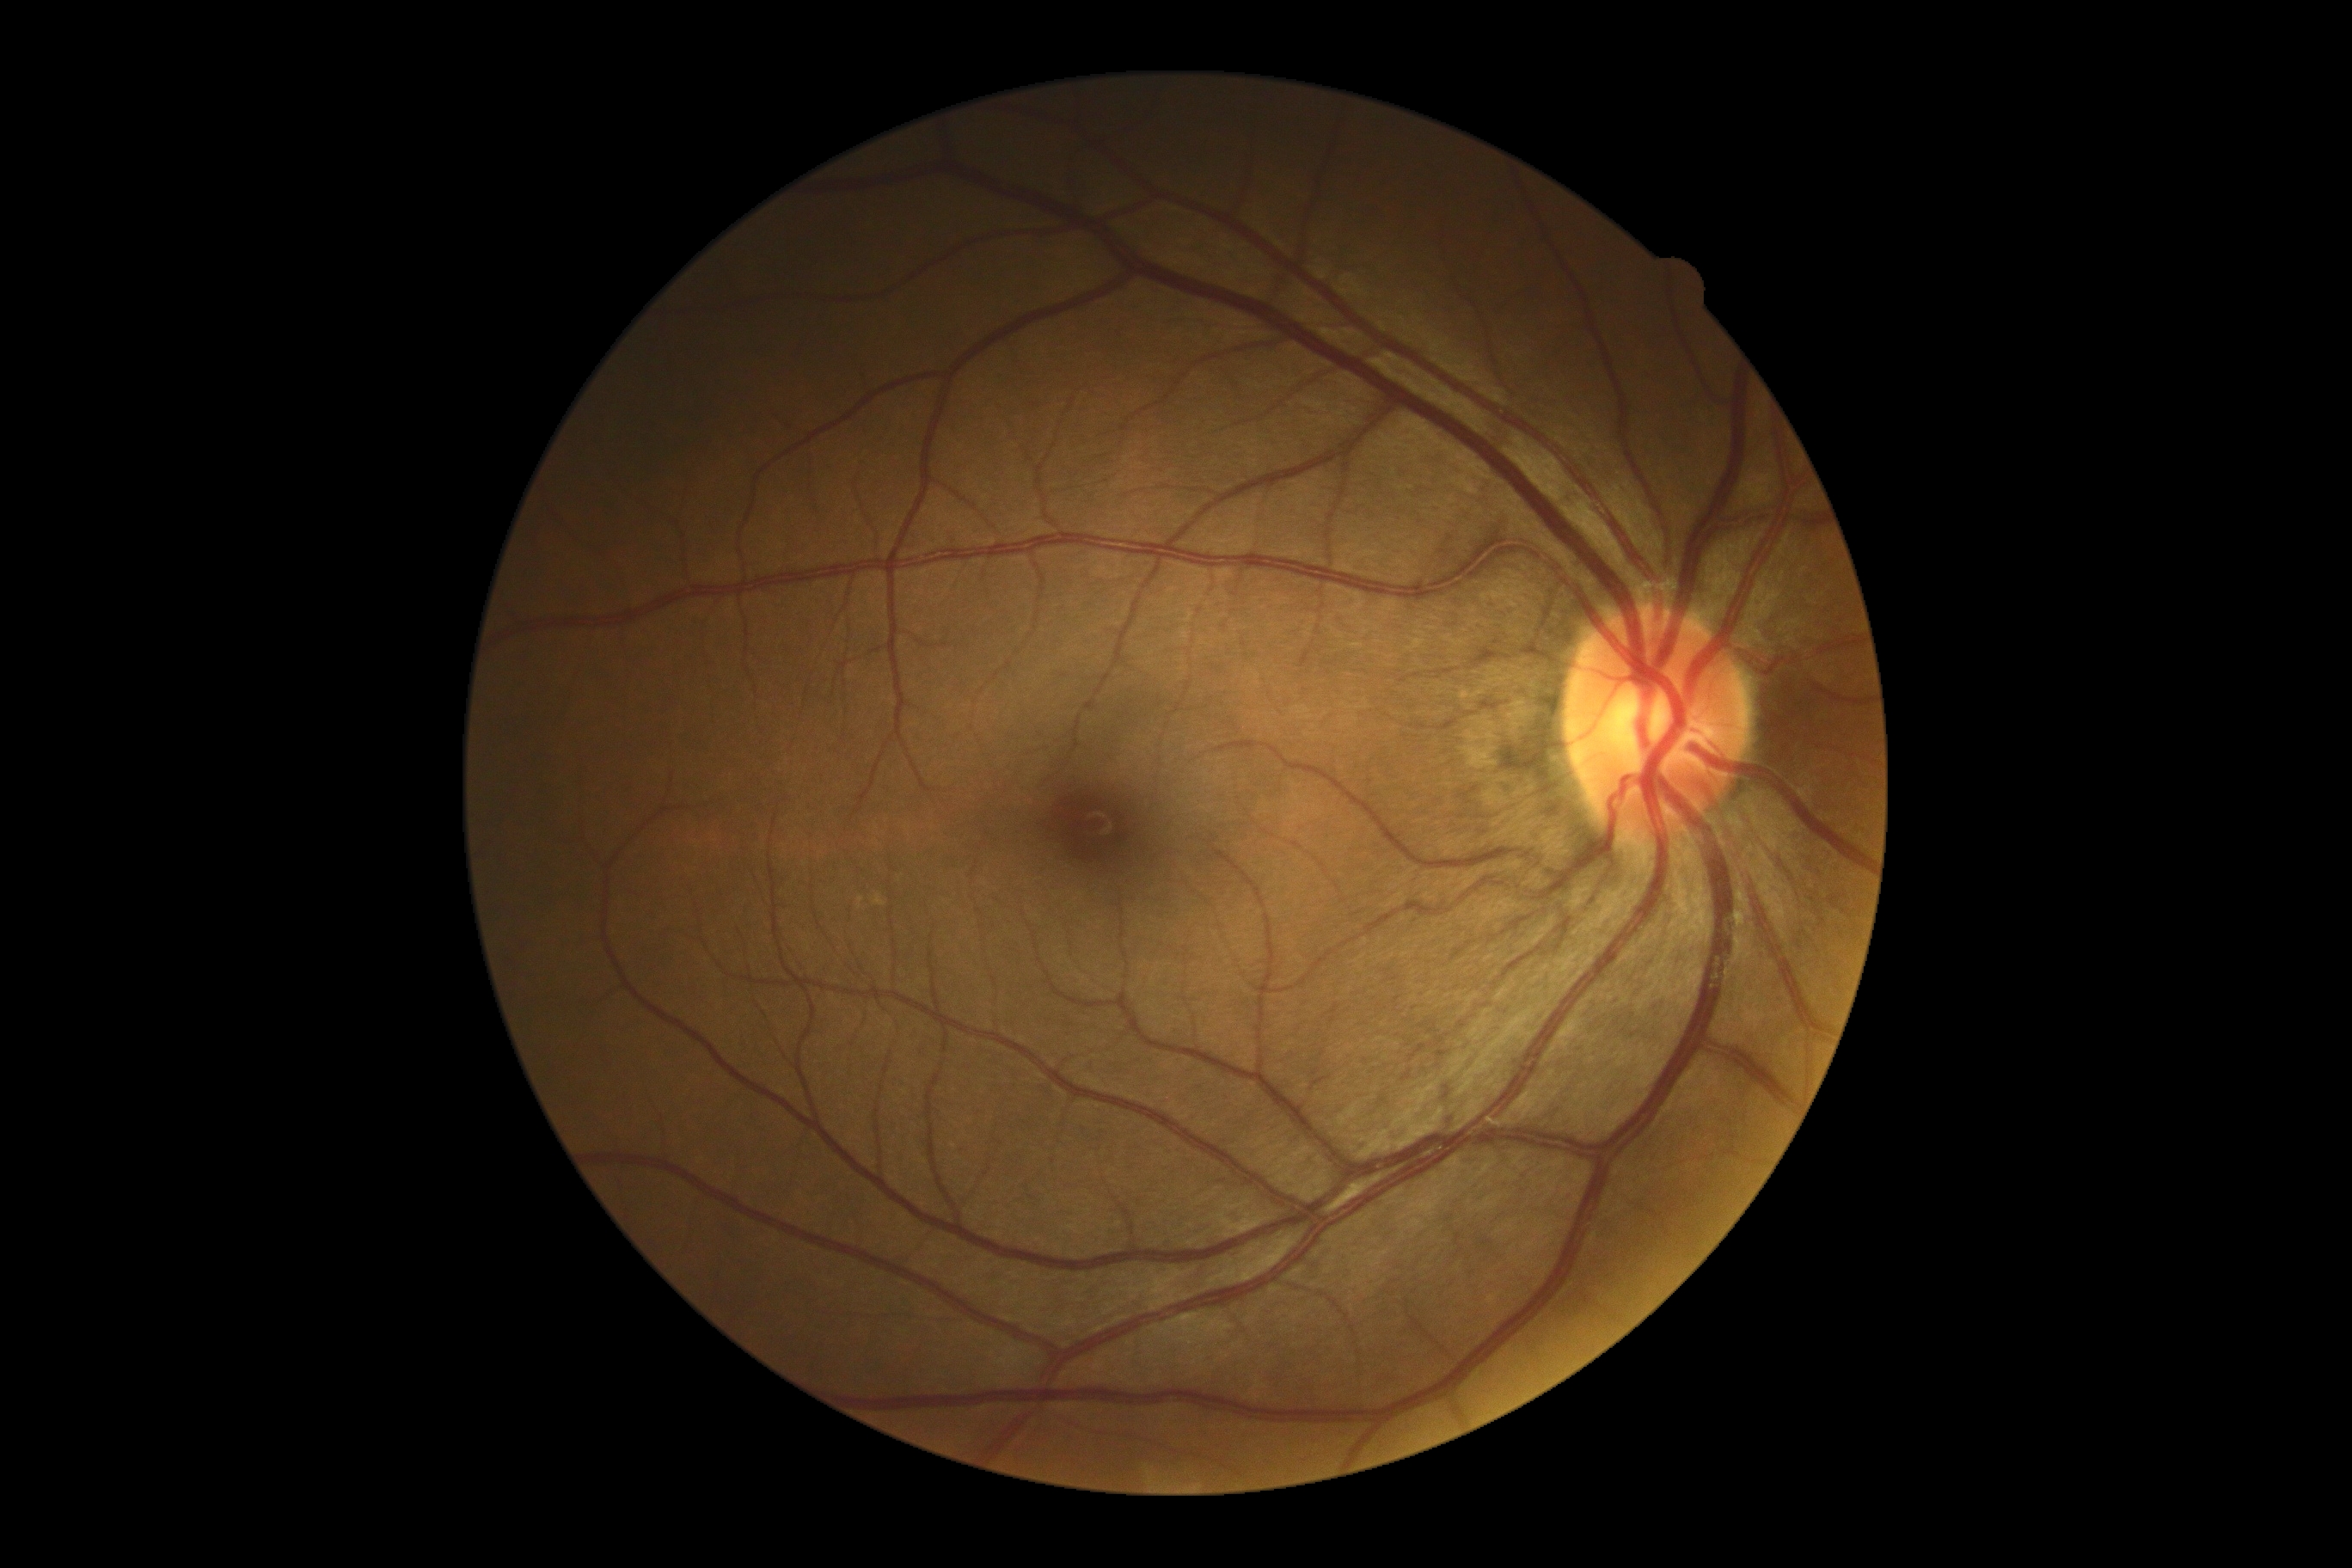
No DR findings. Diabetic retinopathy (DR): 0/4.